Graded on the modified Davis scale:
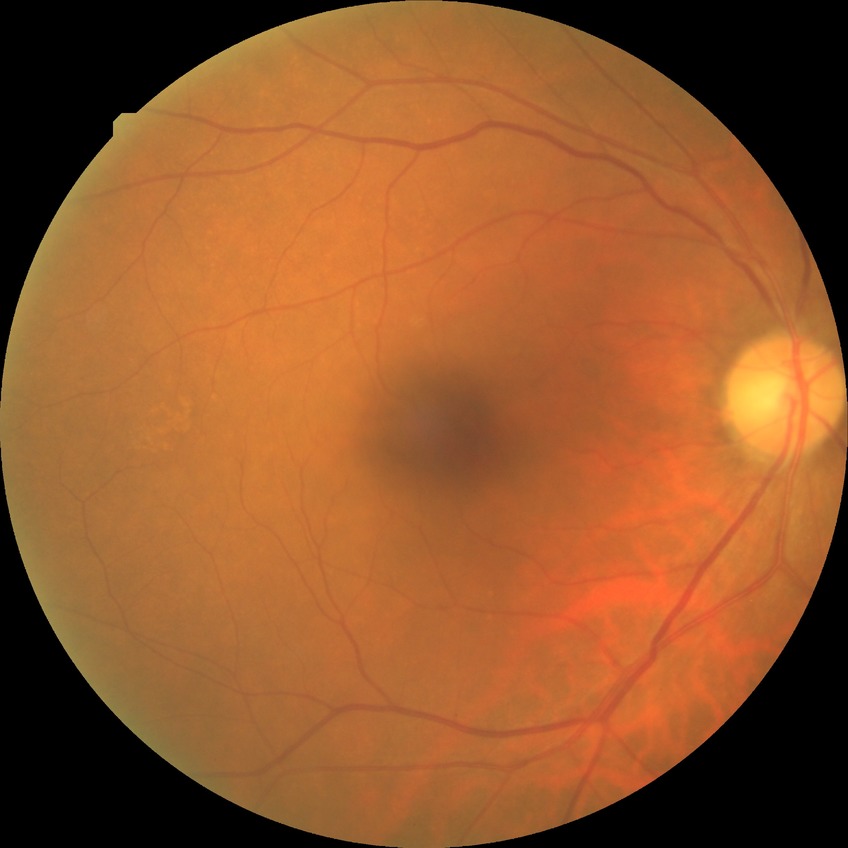
  davis_grade: no diabetic retinopathy (NDR)